50-degree field of view — 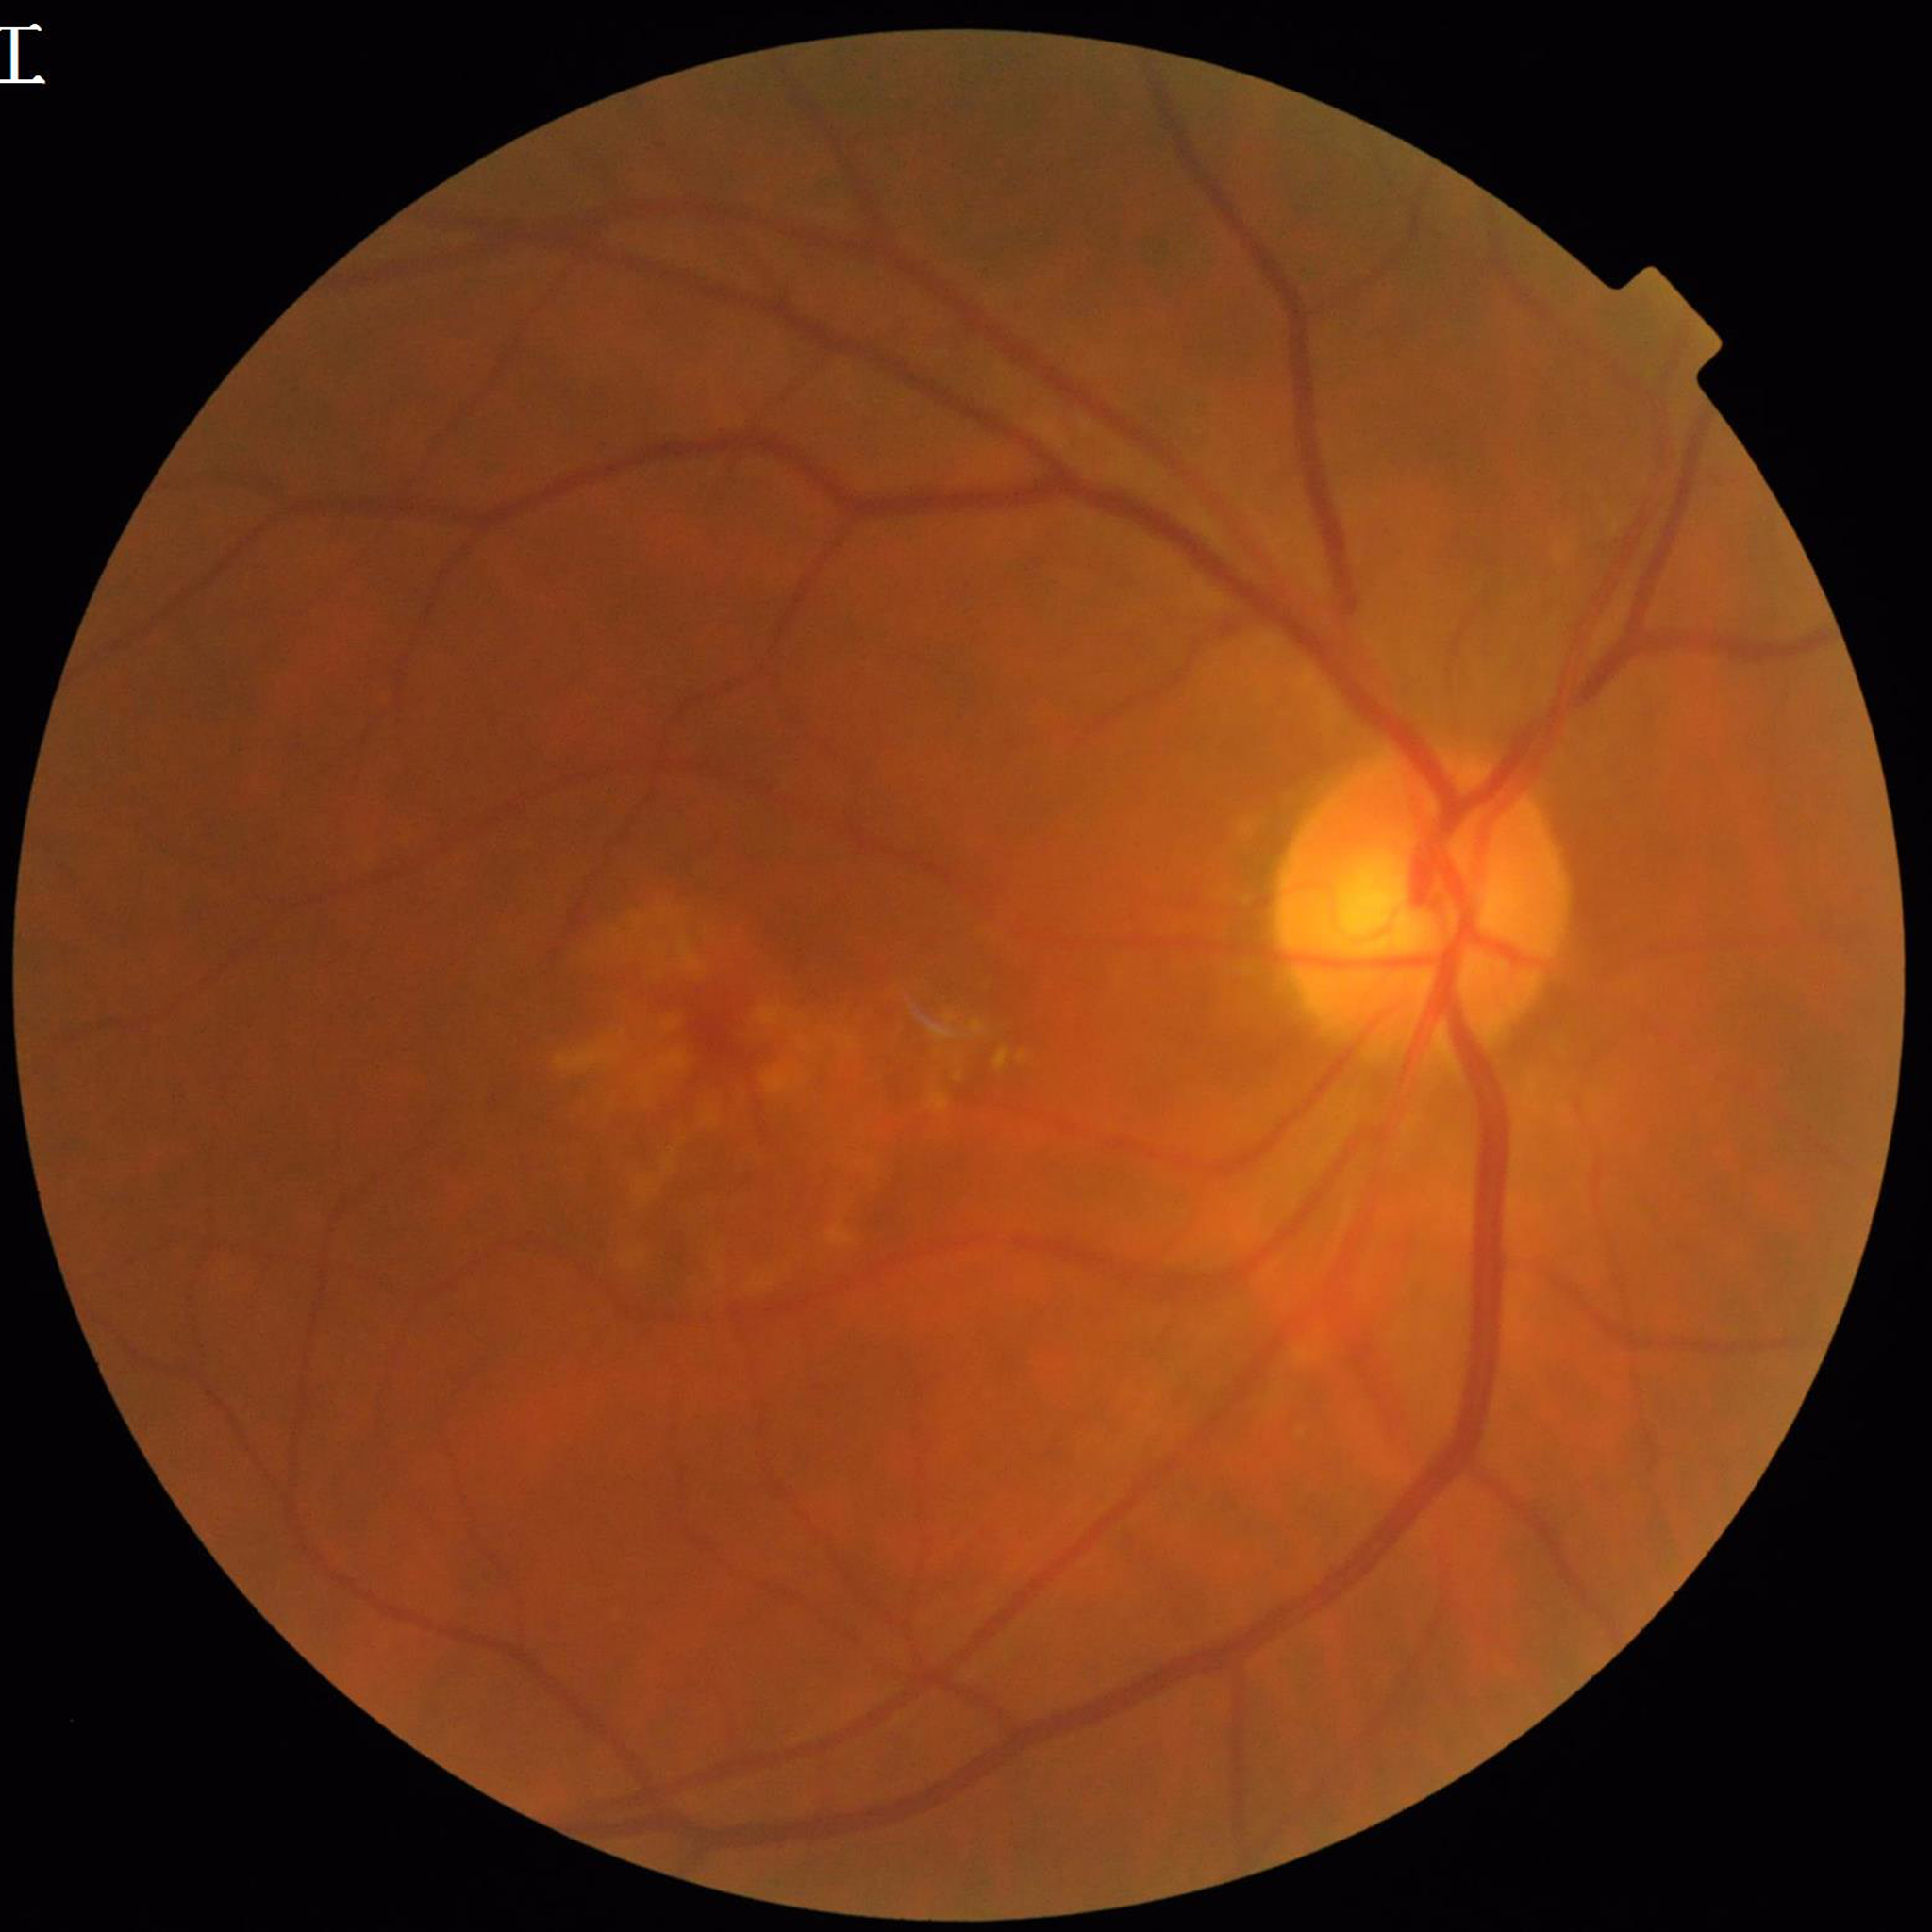

Eye affected by AMD. Image quality: no concerns identified.